100° field of view (Phoenix ICON). 1240 by 1240 pixels. Infant wide-field fundus photograph.
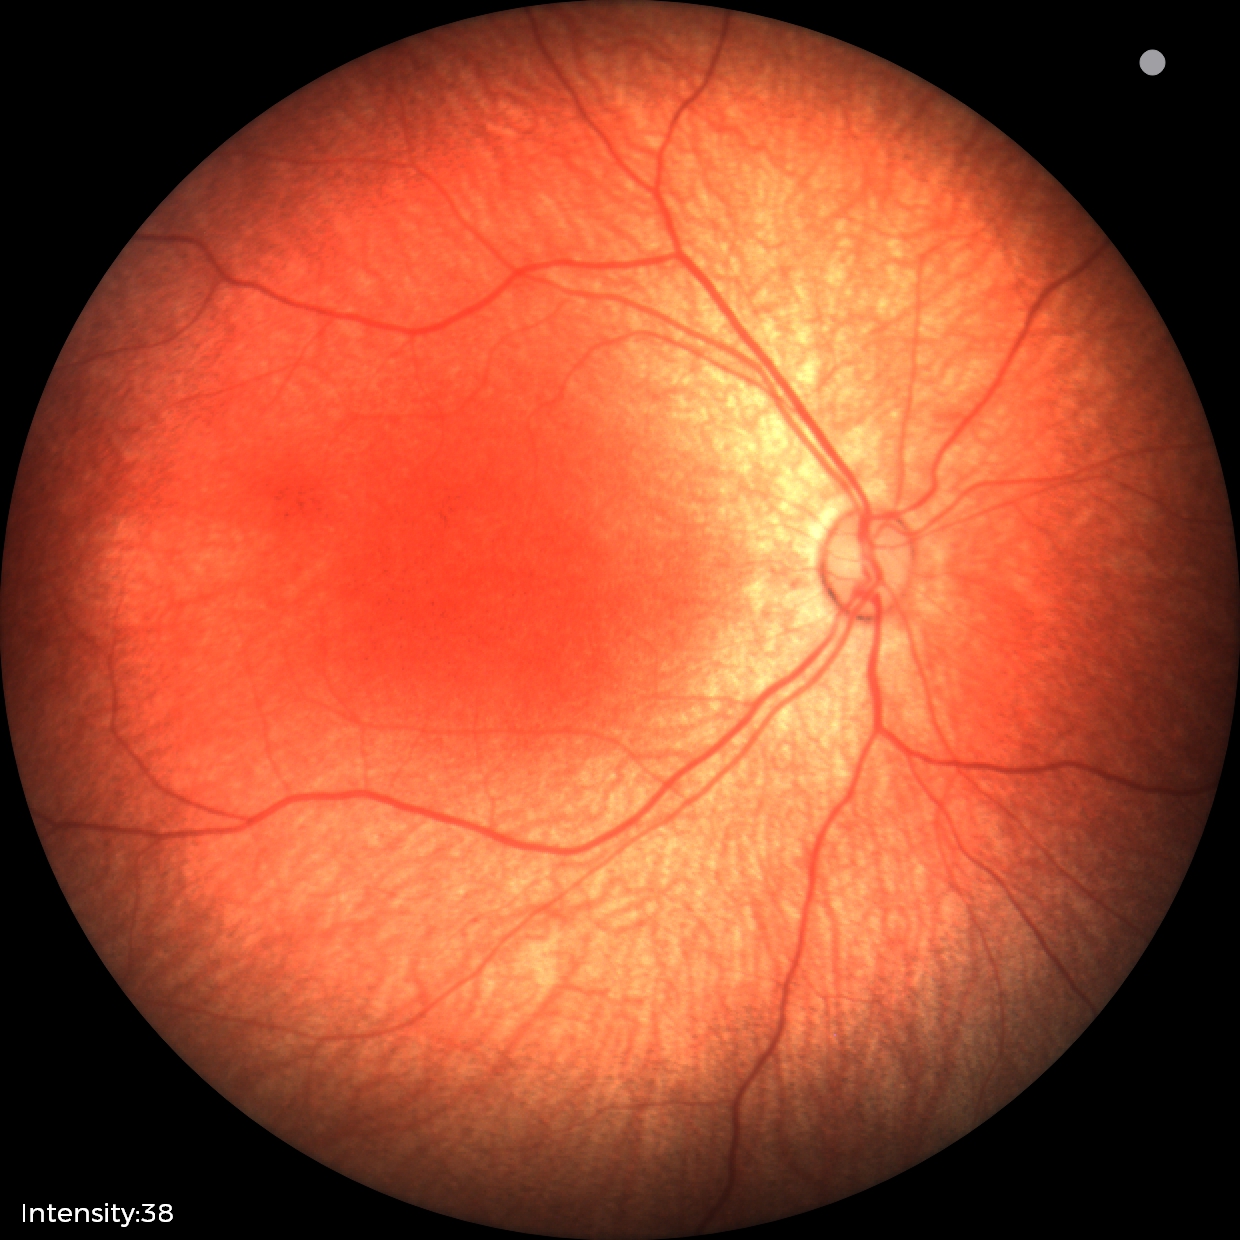

Q: What was the screening finding?
A: physiological appearance with no retinal pathology